FOV: 45 degrees
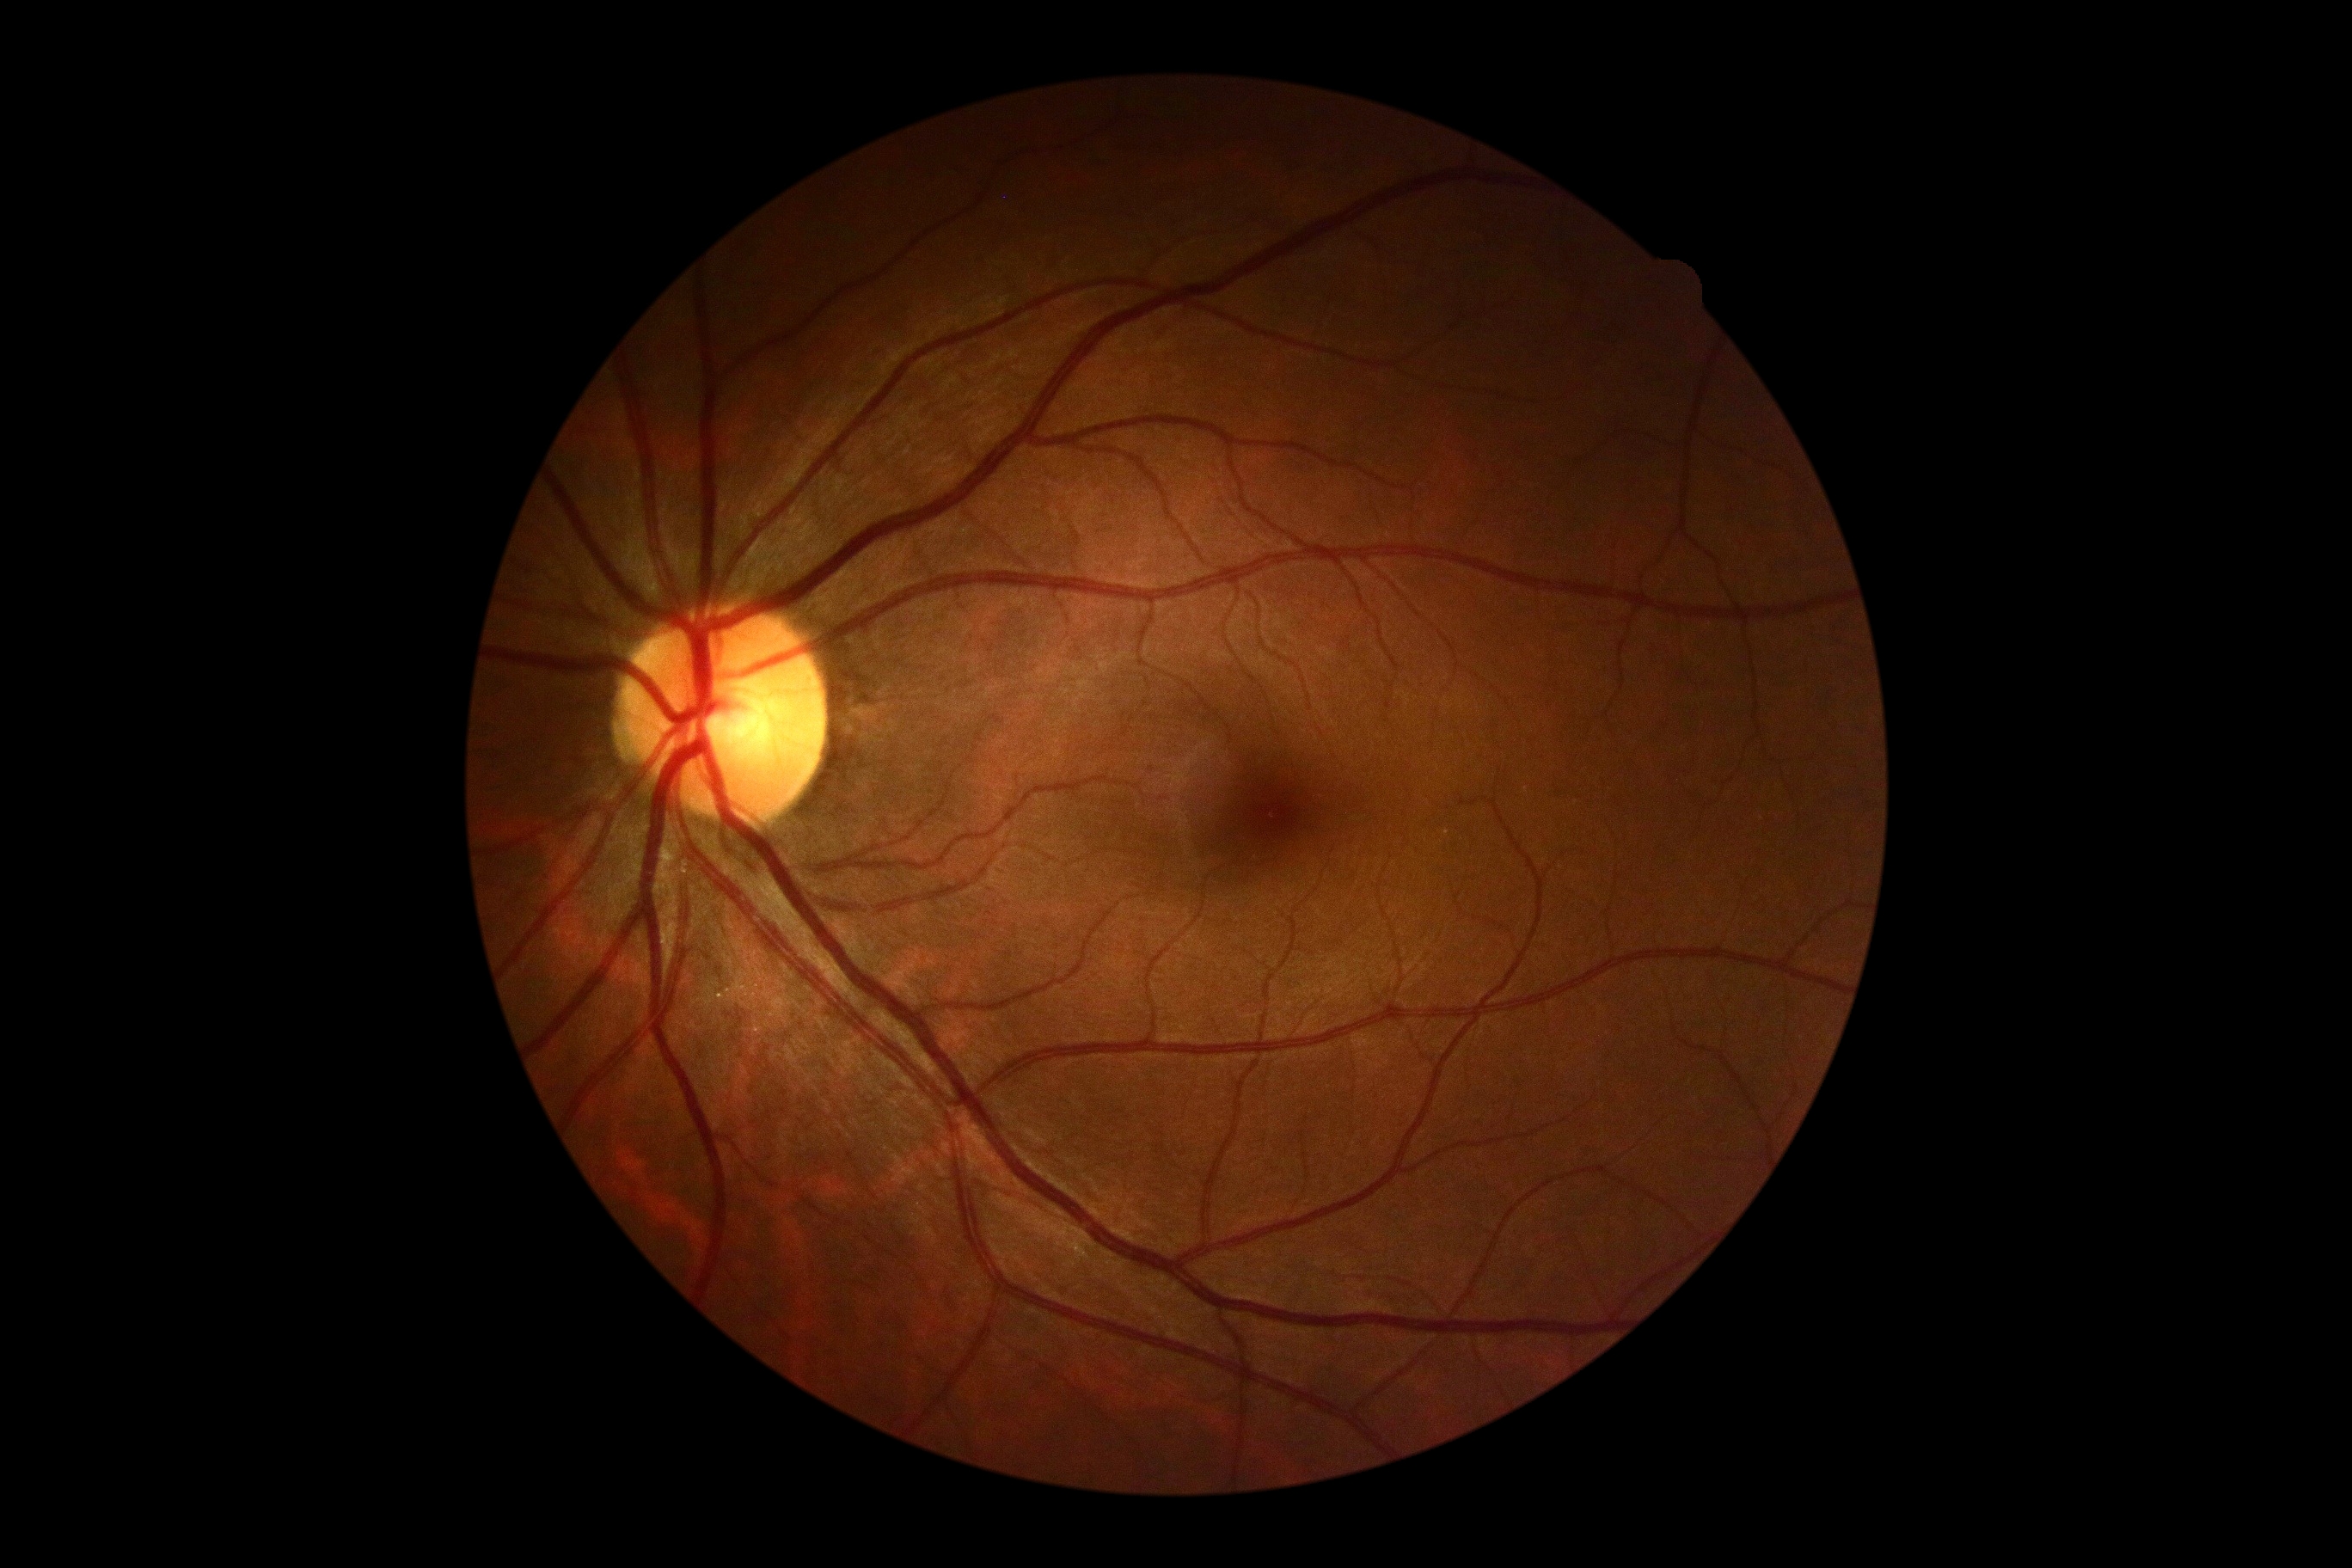 Findings:
• DR severity — grade 0 (no apparent retinopathy)
• DR impression — no DR findings